45° field of view; retinal fundus photograph
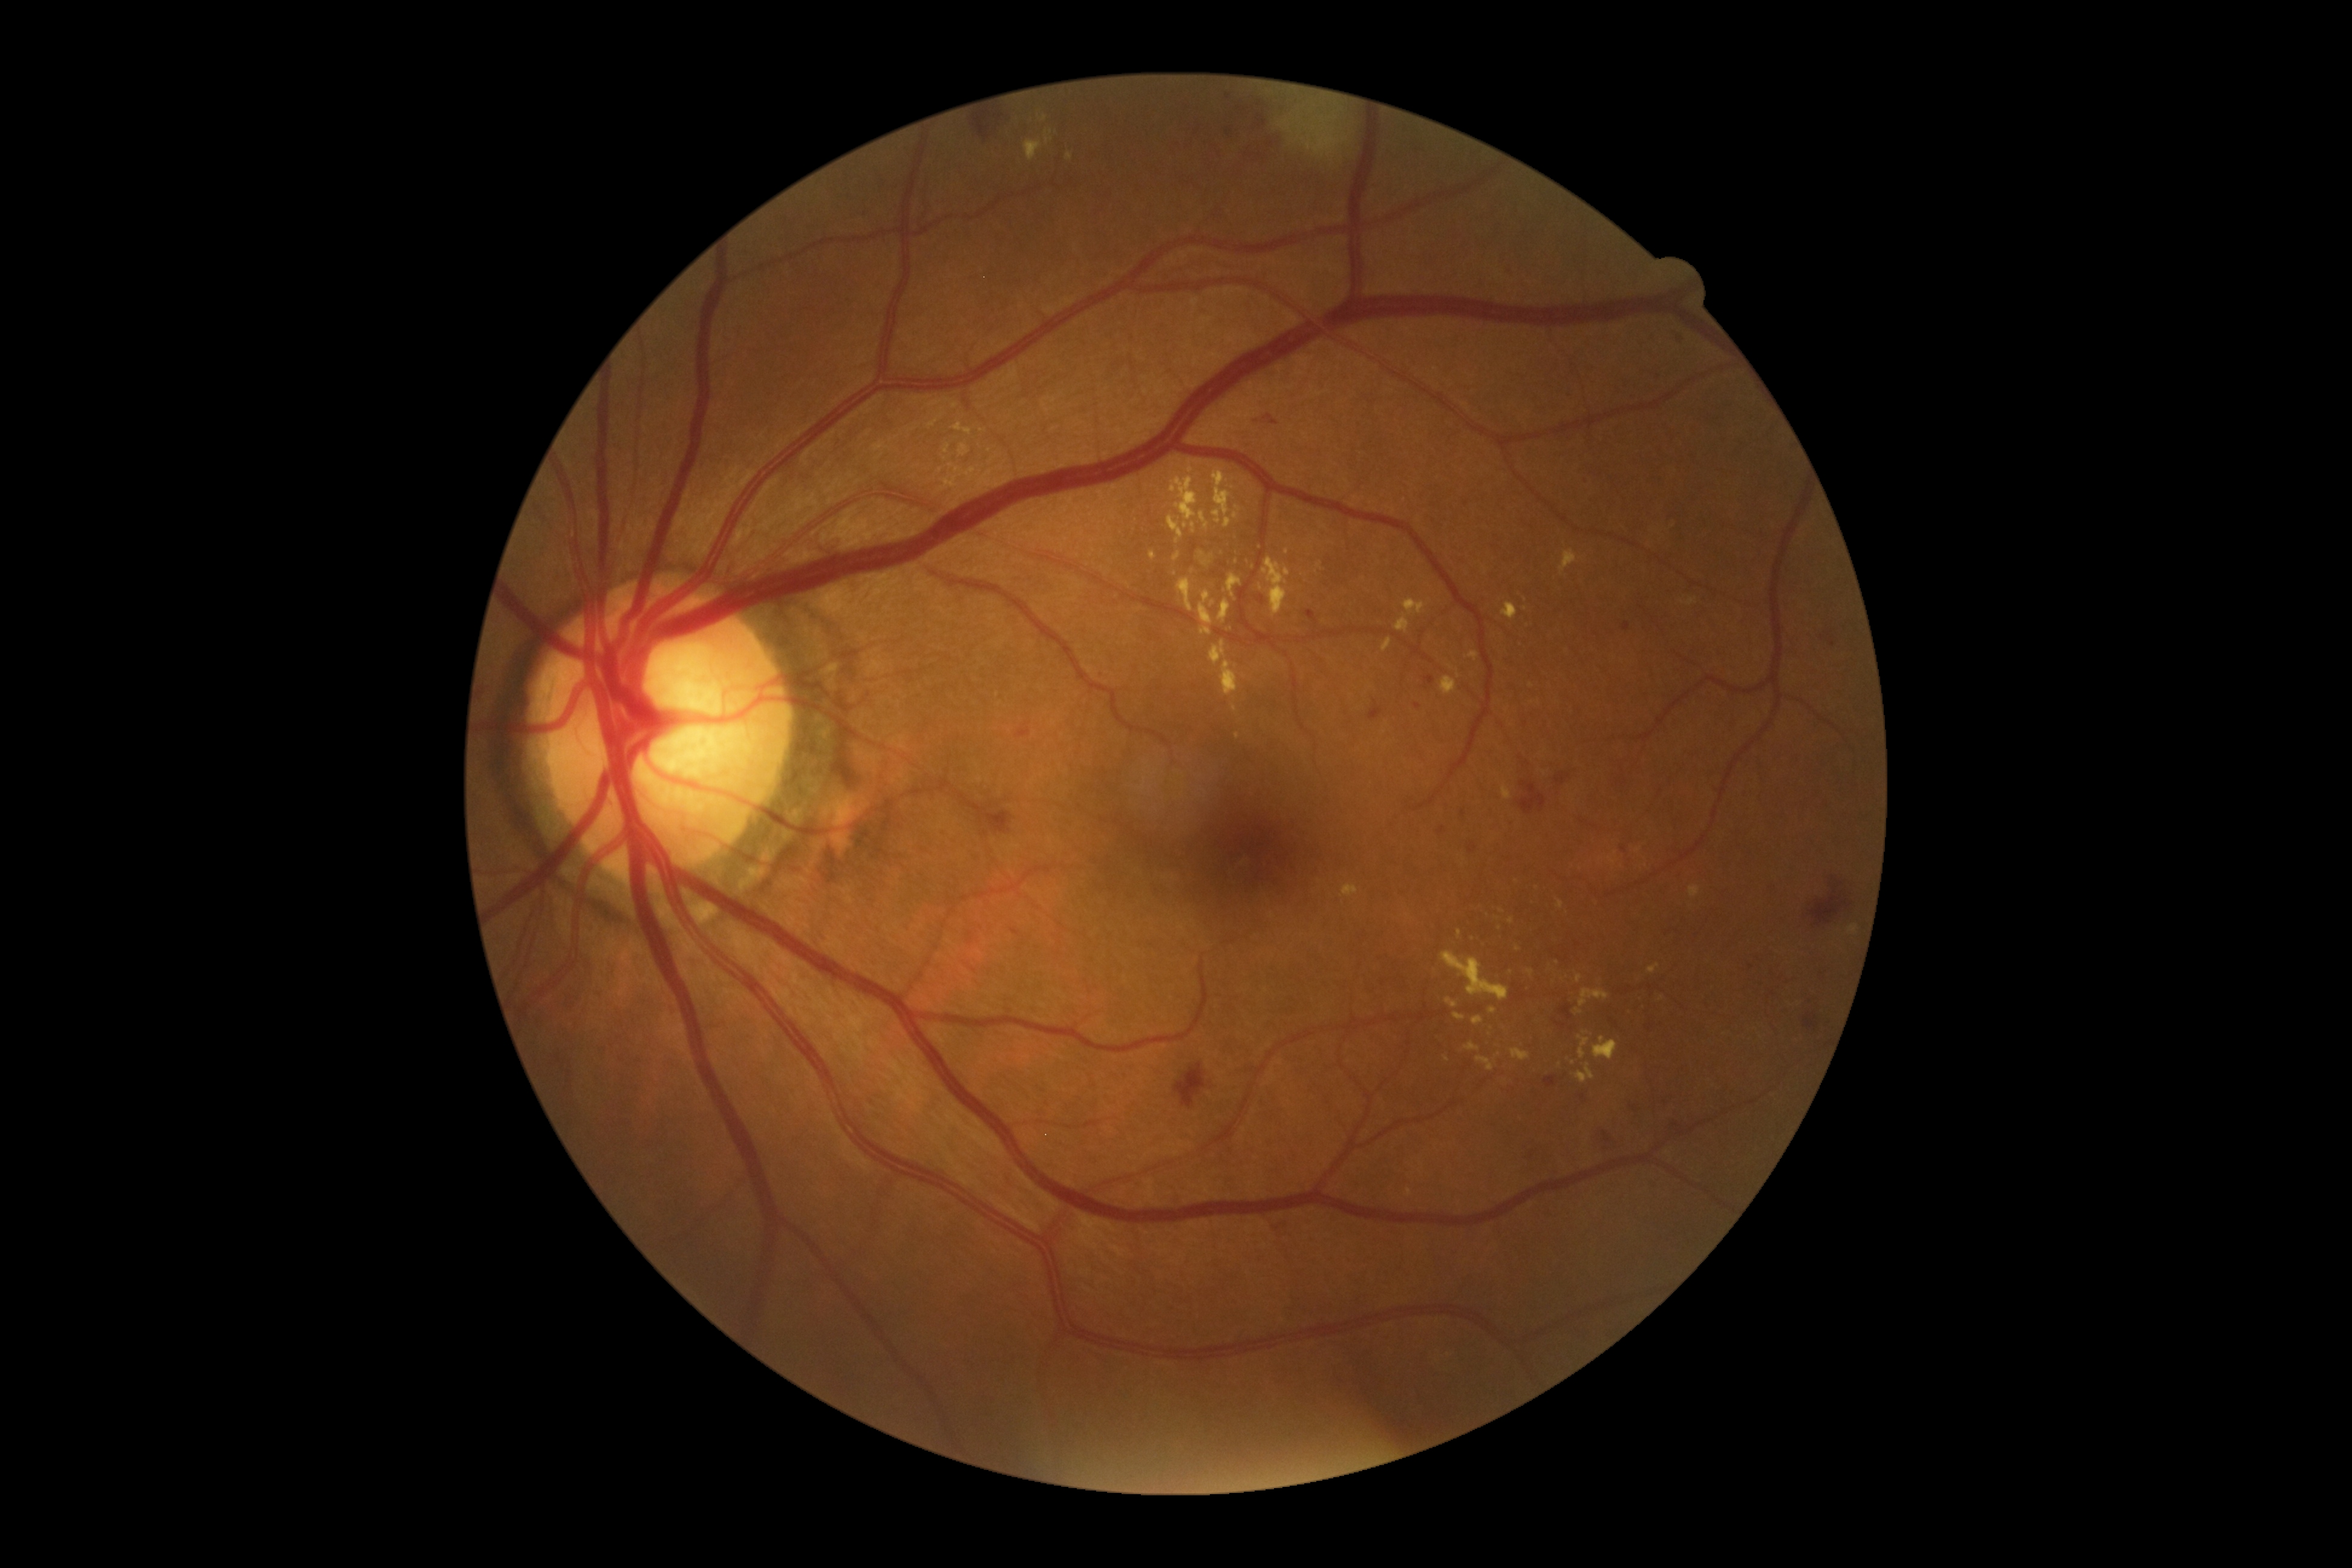 Diabetic retinopathy (DR): grade 2 (moderate NPDR)
A subset of detected lesions:
hard exudates (EXs) (more not shown): x1=1576, y1=973, x2=1583, y2=983; x1=1647, y1=964, x2=1659, y2=975; x1=943, y1=443, x2=952, y2=454; x1=1527, y1=969, x2=1535, y2=977; x1=1219, y1=599, x2=1231, y2=624; x1=1198, y1=591, x2=1215, y2=635; x1=1559, y1=549, x2=1577, y2=575; x1=1688, y1=885, x2=1700, y2=898; x1=1210, y1=641, x2=1226, y2=666; x1=1171, y1=476, x2=1209, y2=531
Smaller EXs around Point(1238, 508); Point(1559, 1064); Point(1193, 571); Point(1319, 566); Point(1662, 998); Point(1573, 1062)
microaneurysms (MAs) (more not shown): x1=1581, y1=1094, x2=1586, y2=1104; x1=1648, y1=1181, x2=1656, y2=1186; x1=1305, y1=610, x2=1318, y2=624; x1=1623, y1=622, x2=1630, y2=631; x1=1256, y1=595, x2=1264, y2=604; x1=1559, y1=1005, x2=1573, y2=1021; x1=1425, y1=676, x2=1436, y2=685; x1=1438, y1=826, x2=1446, y2=834
Smaller MAs around Point(1650, 1027); Point(1683, 341); Point(1676, 1125)